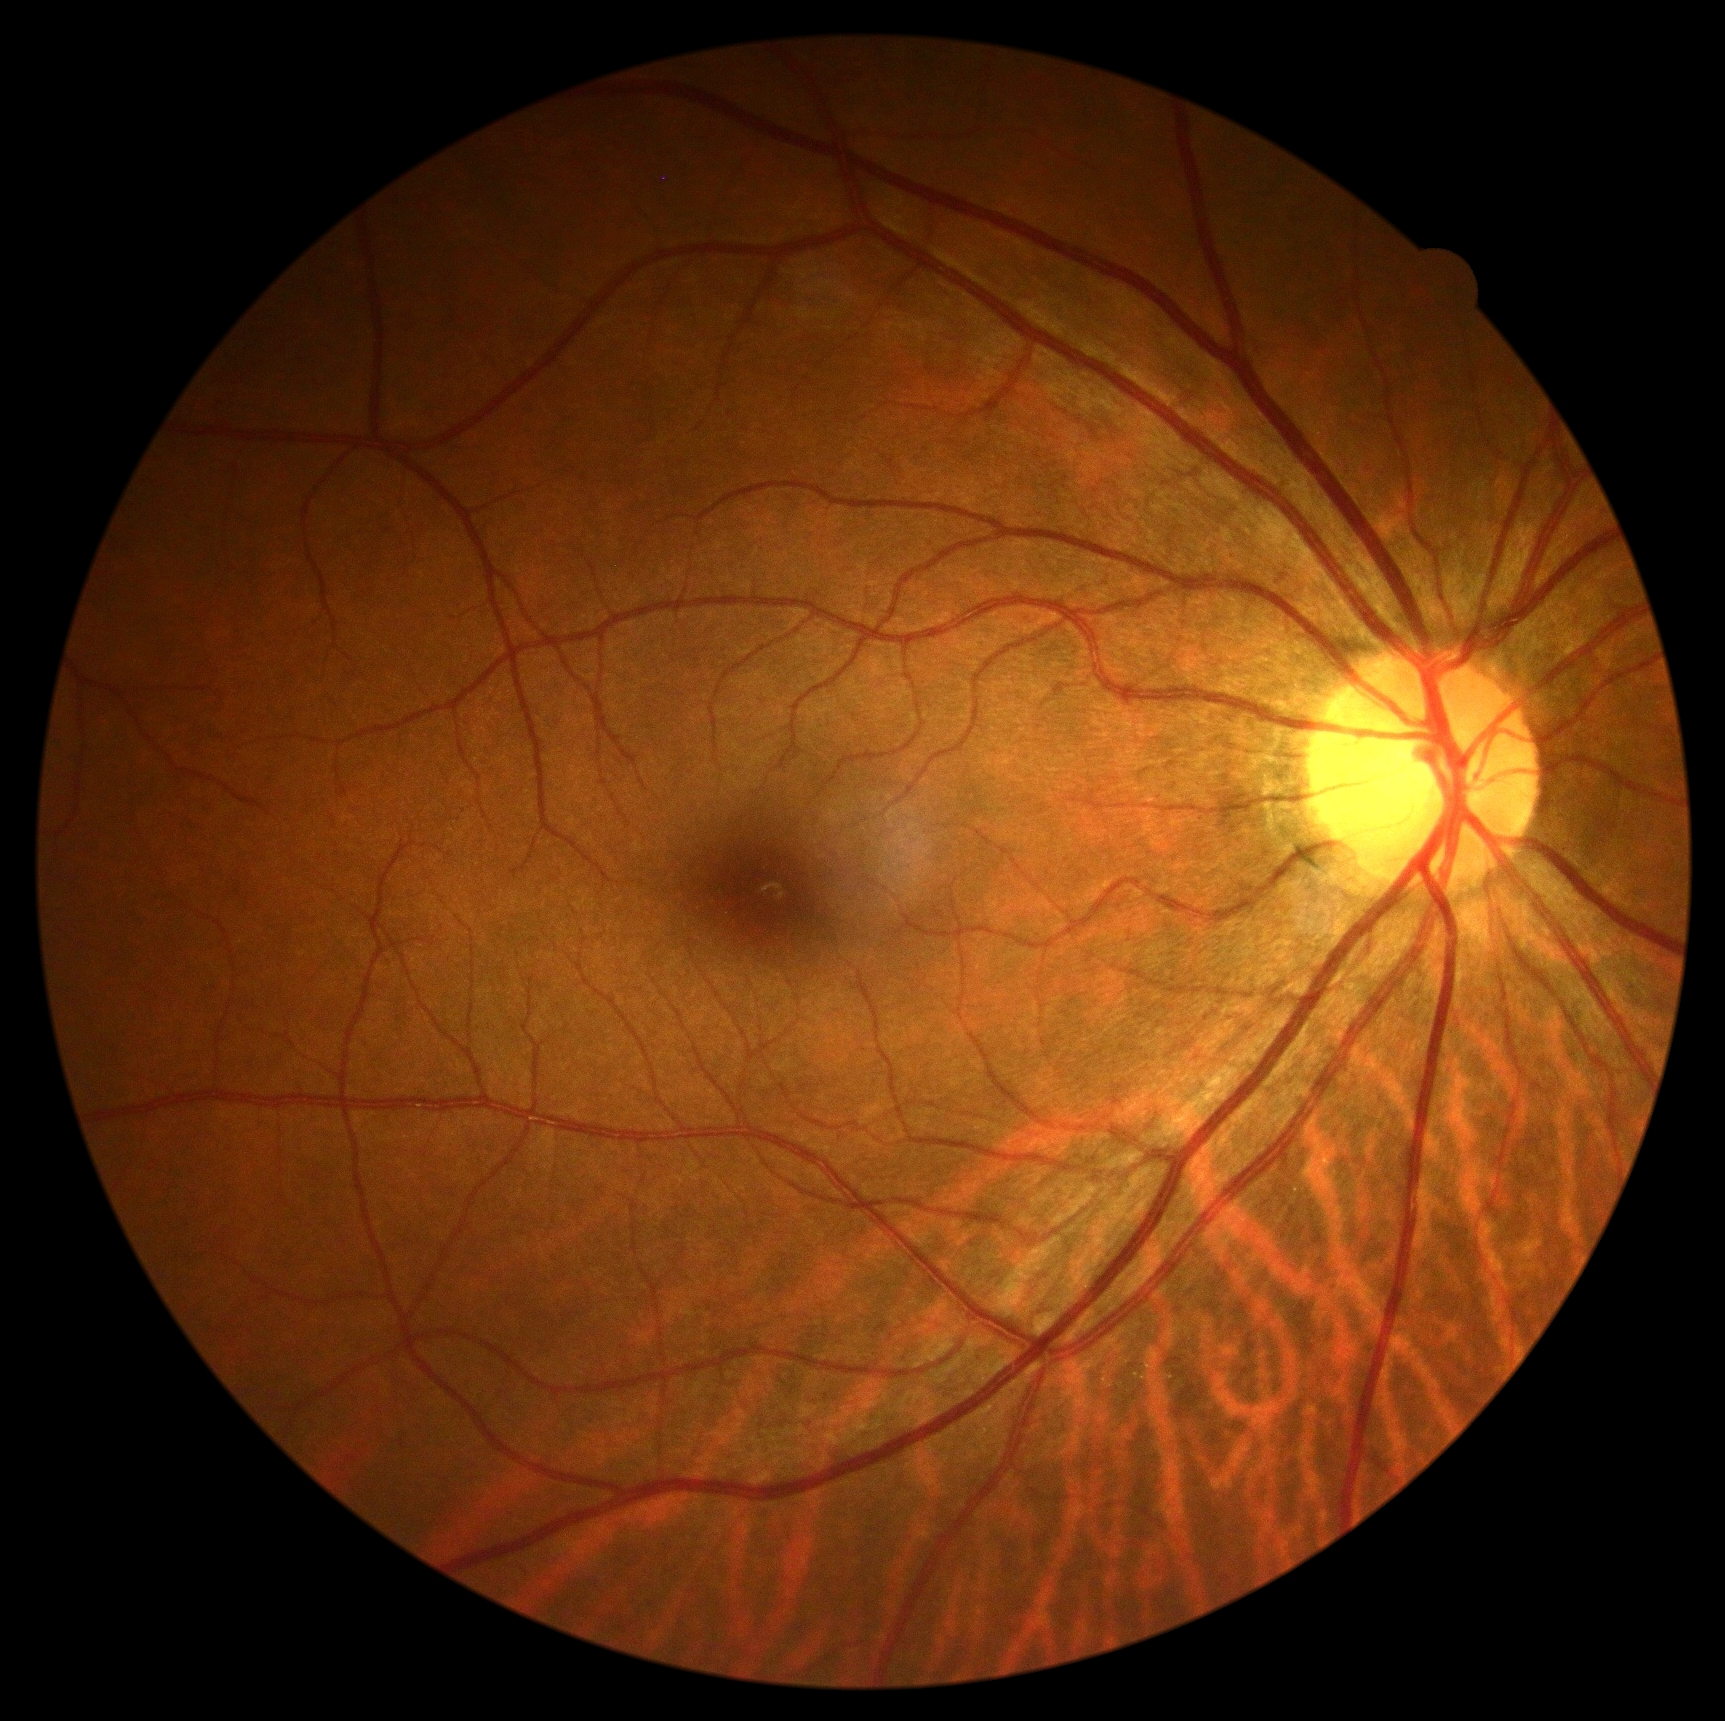
diabetic retinopathy (DR)@no apparent diabetic retinopathy (grade 0).